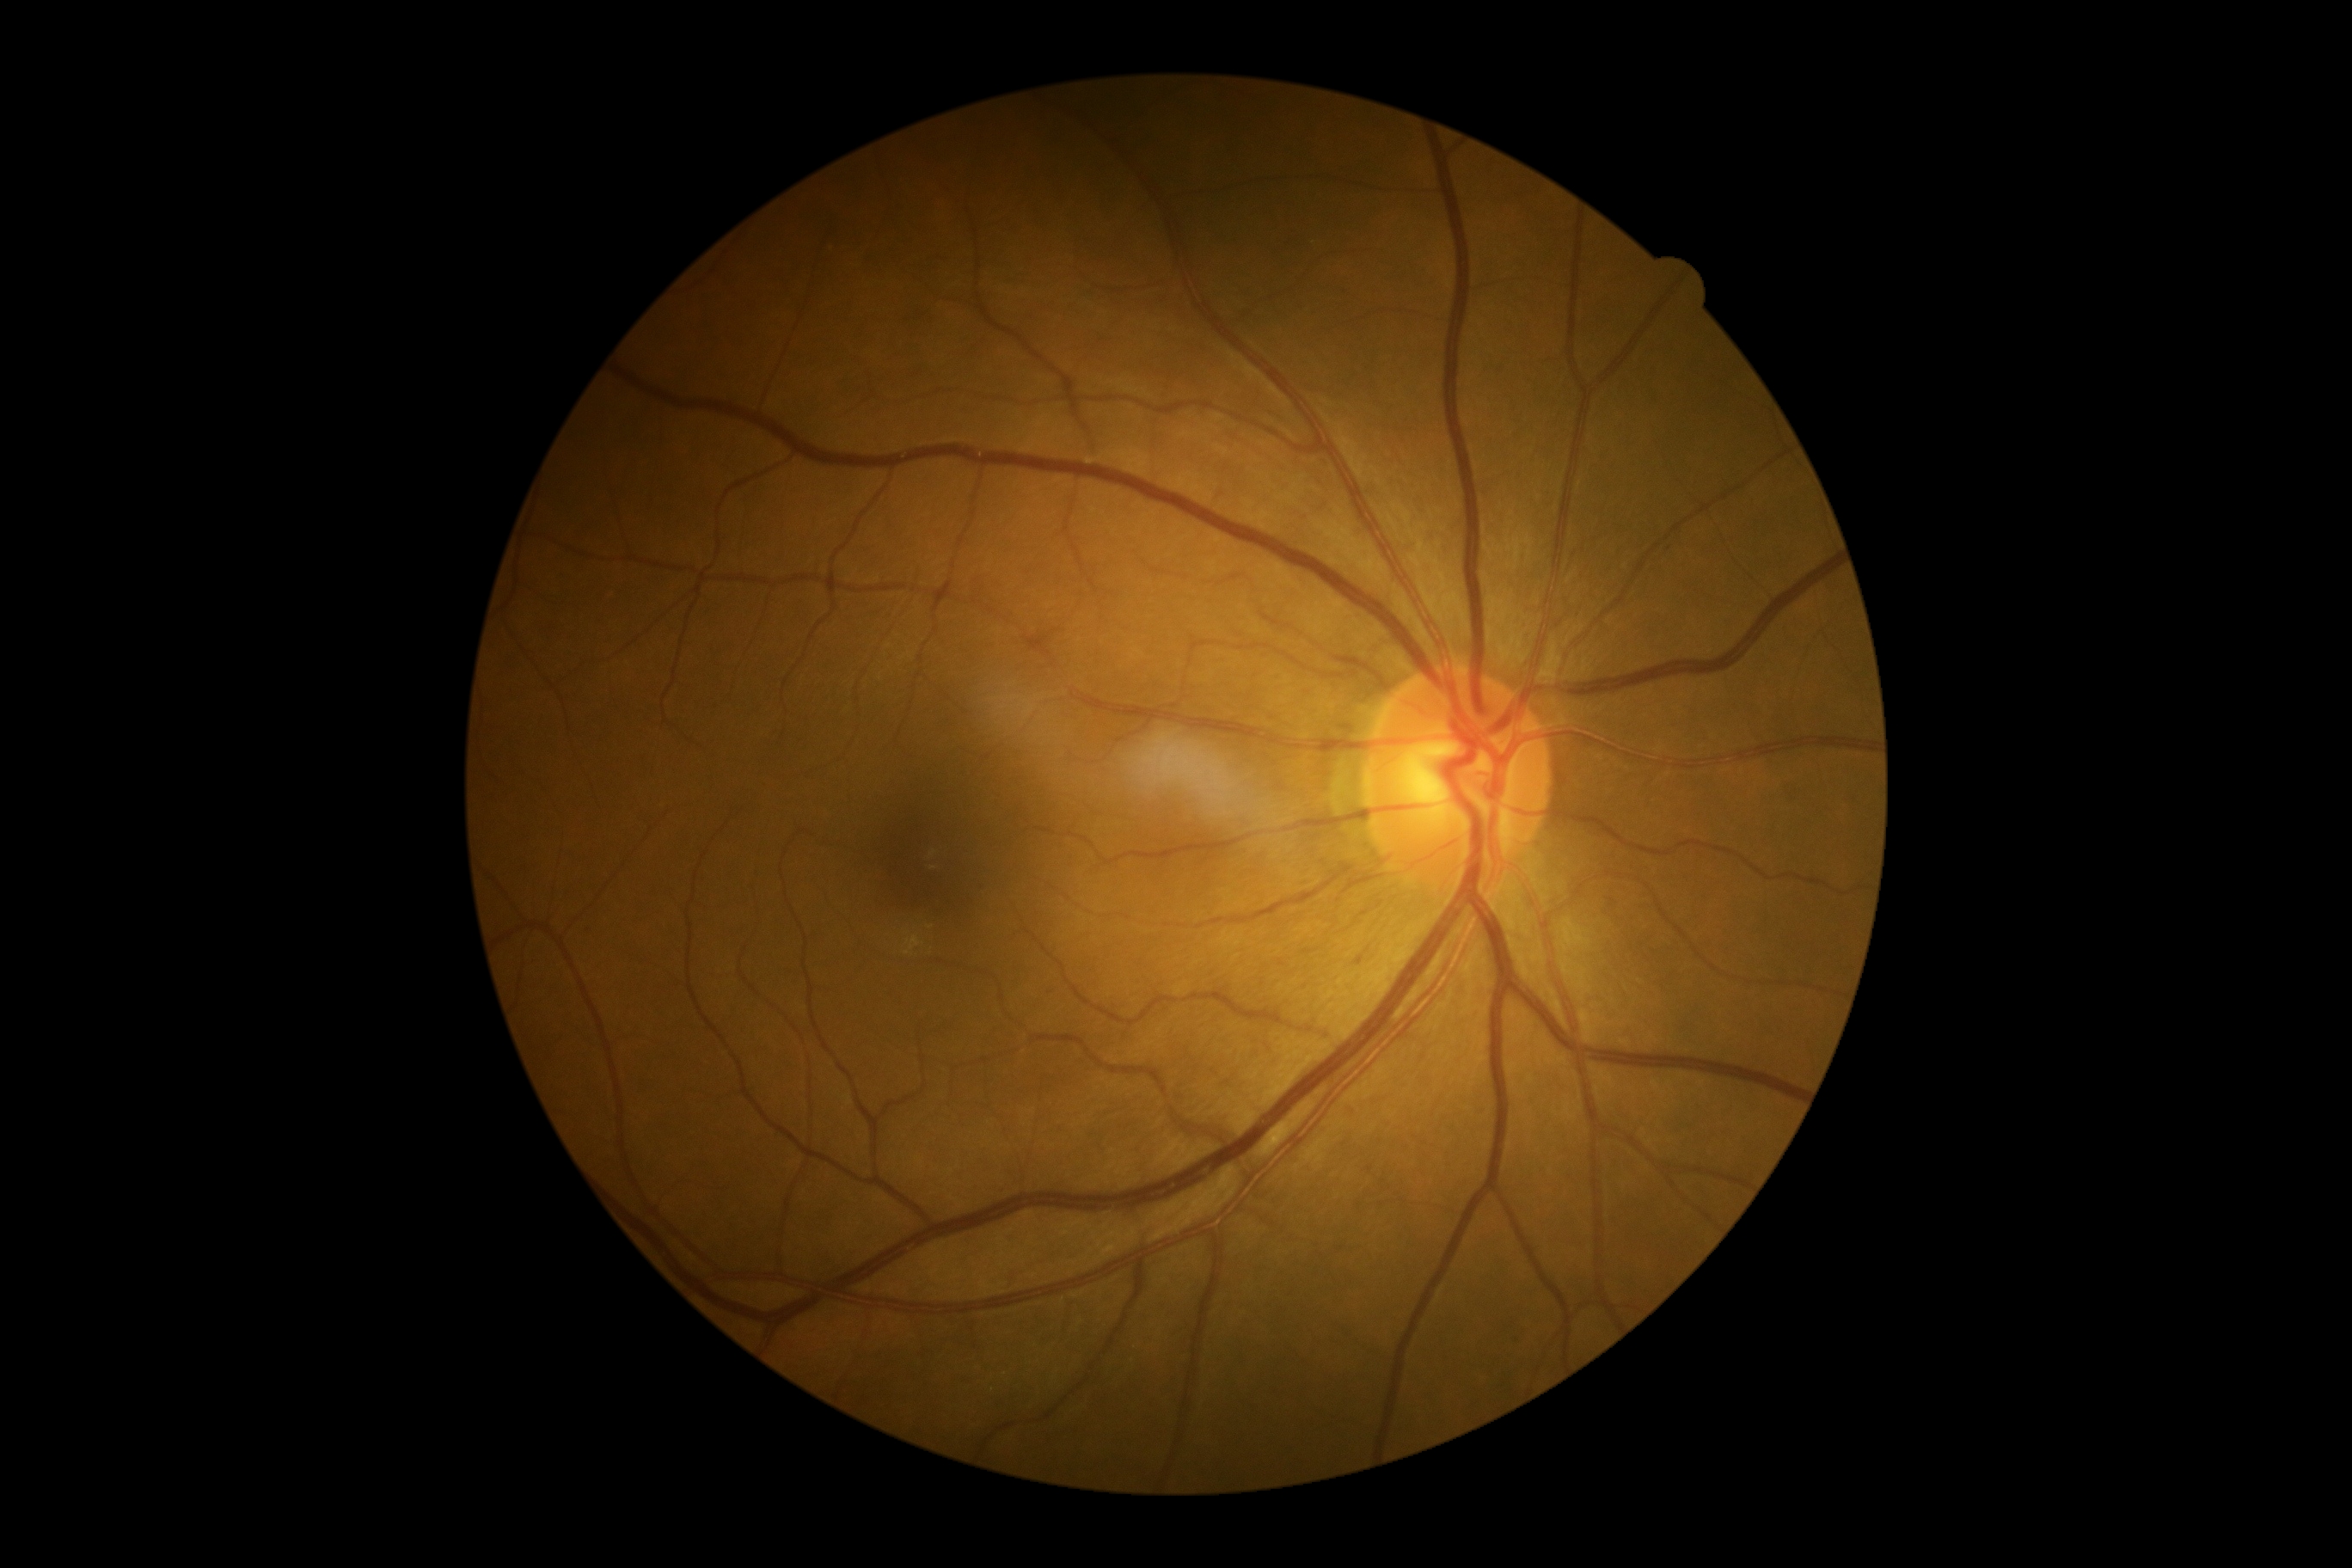 DR is grade 0. No DR findings.